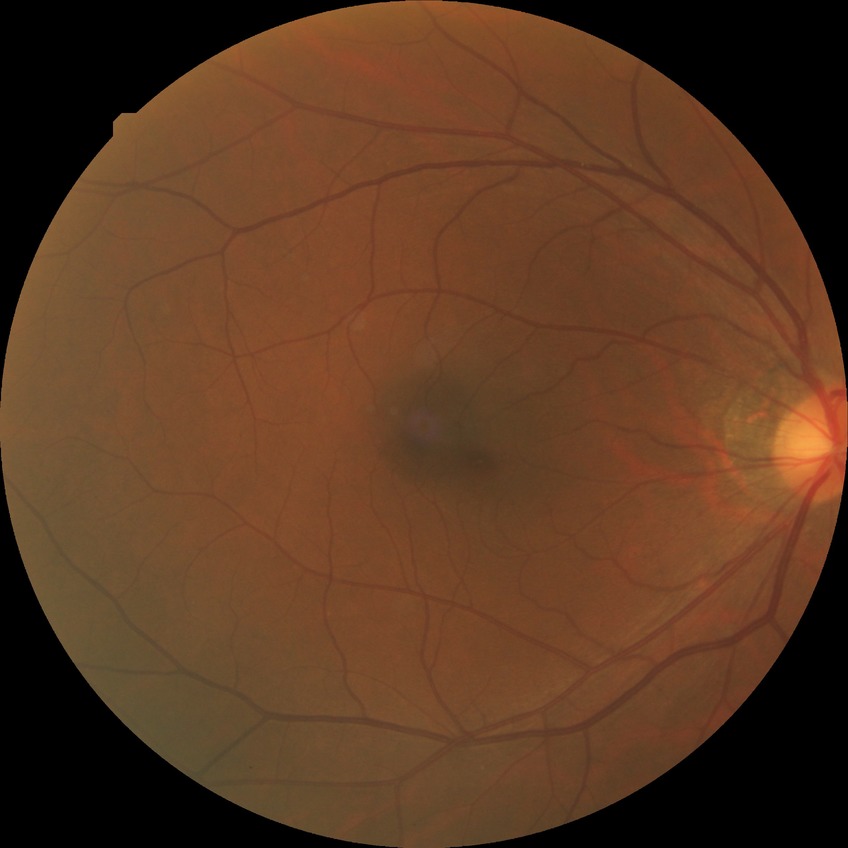 Diabetic retinopathy (DR) is NDR (no diabetic retinopathy).